Acquired on the Clarity RetCam 3 · wide-field fundus photograph from neonatal ROP screening: 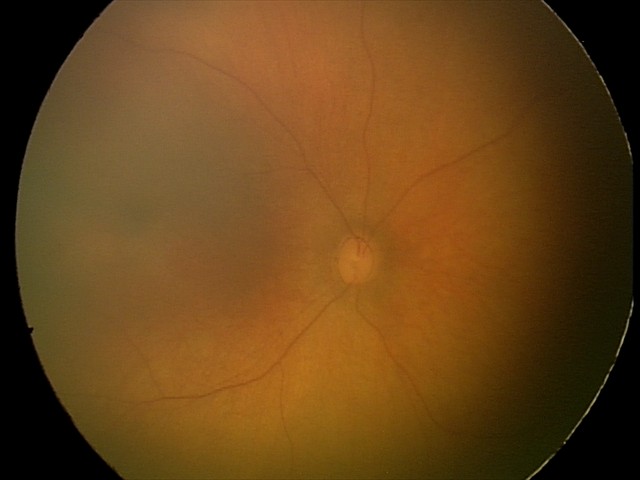 Physiological retinal appearance for postconceptual age.